848x848px — 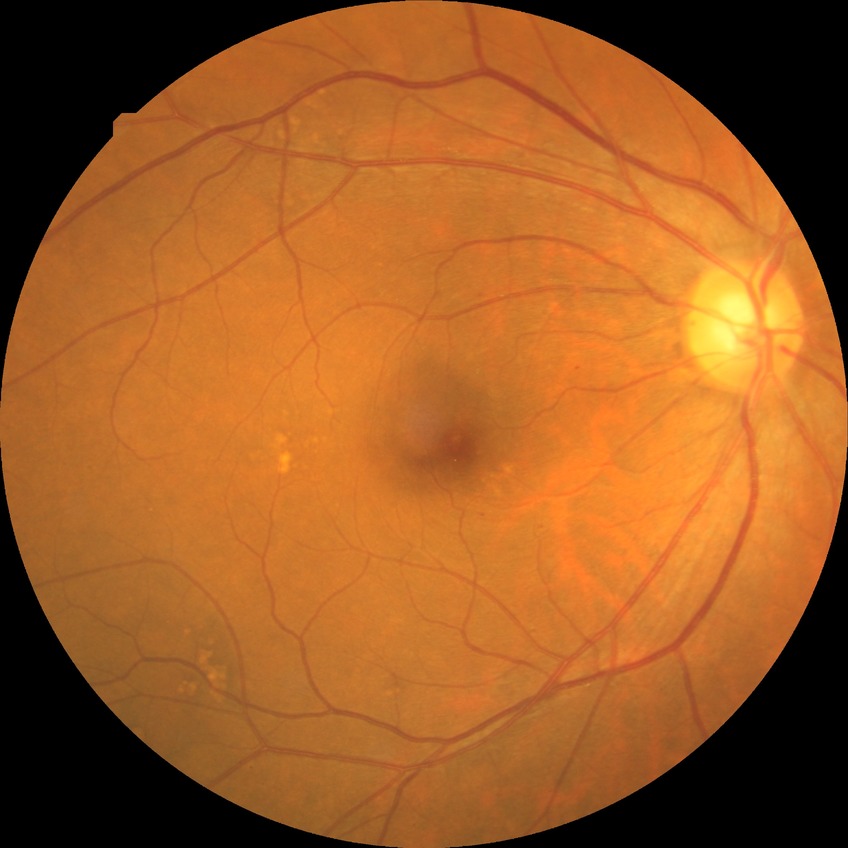

diabetic retinopathy (DR) = SDR (simple diabetic retinopathy).